Optic disc region of a color fundus photo:
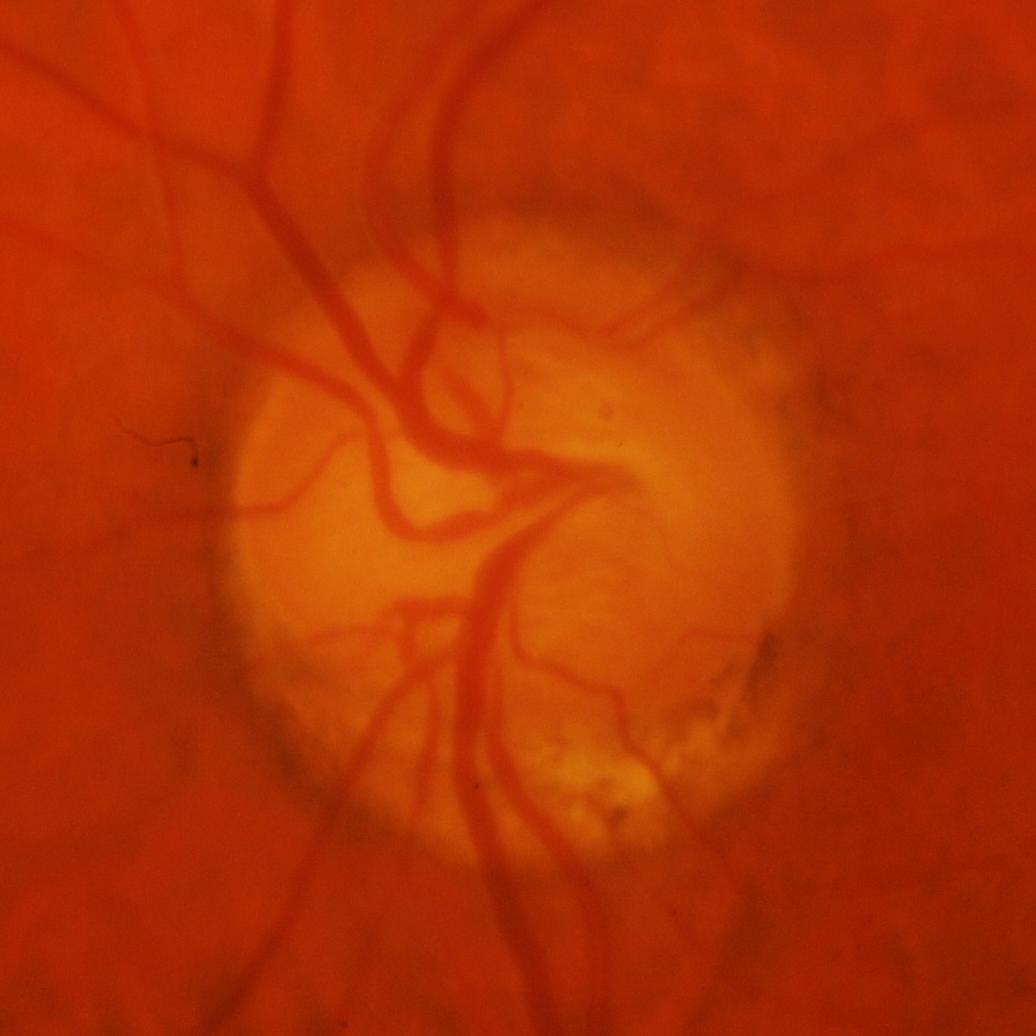
Q: Glaucoma assessment?
A: Yes — glaucomatous findings.